45° field of view · retinal fundus photograph
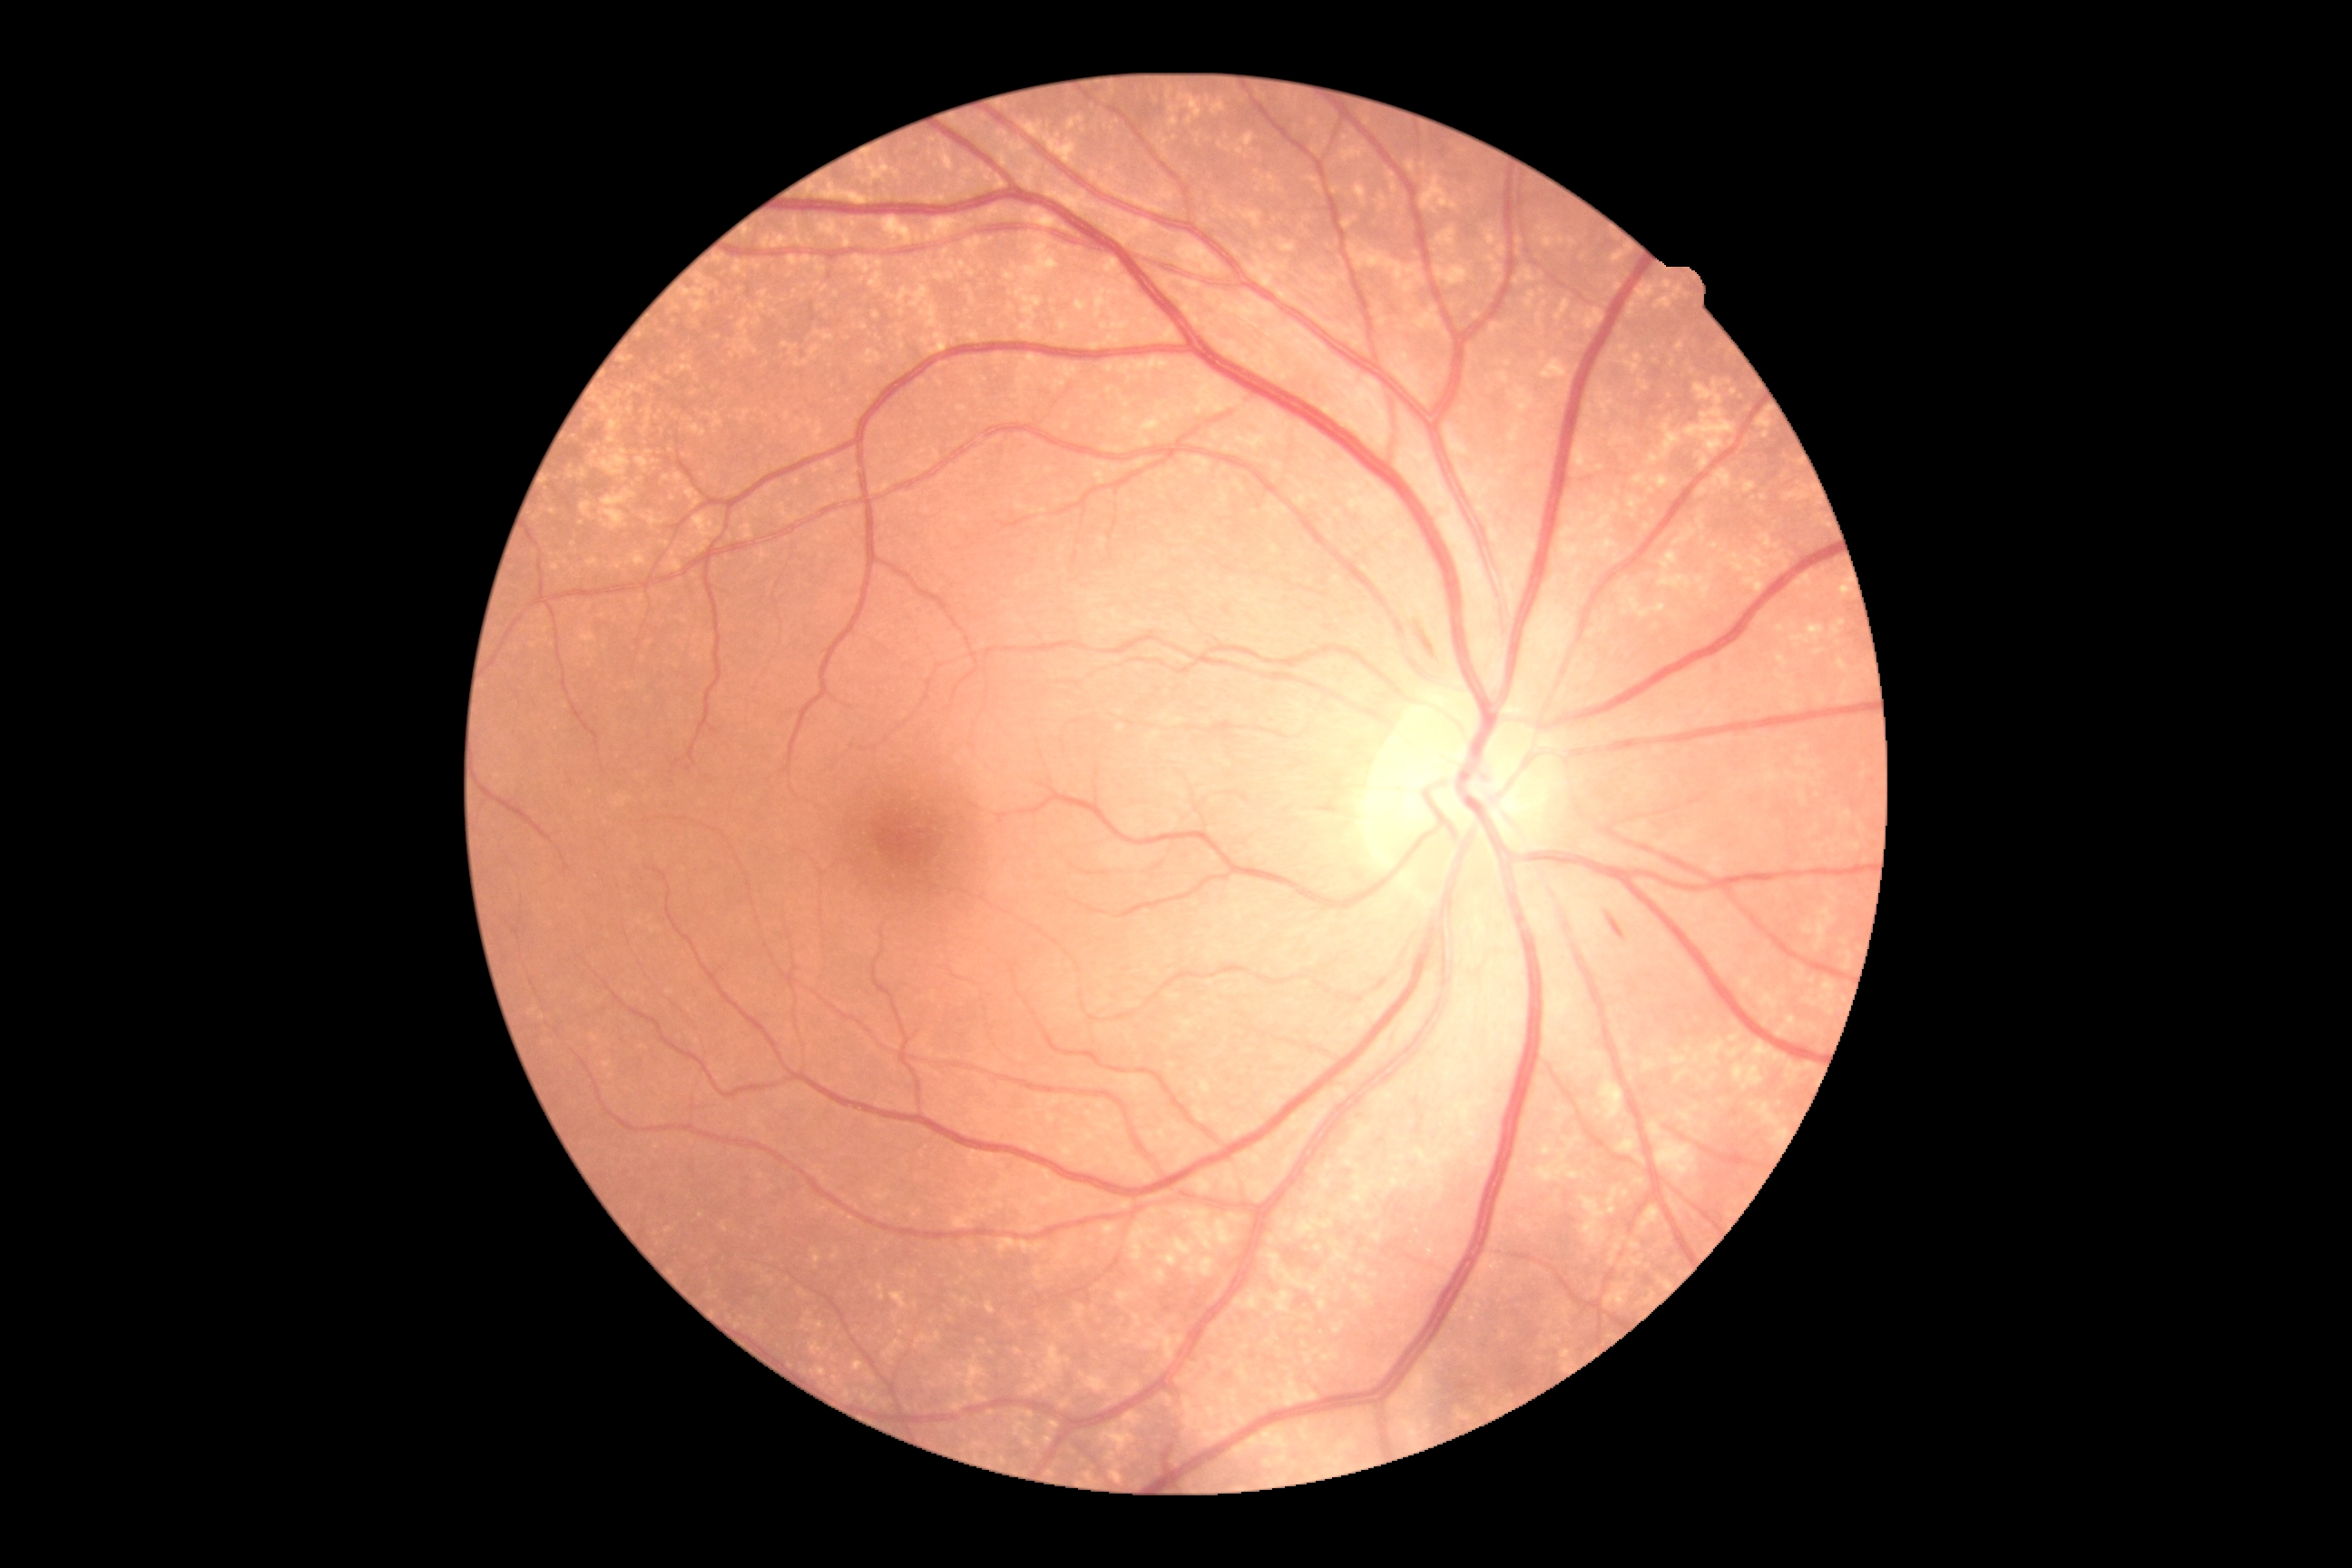
Diabetic retinopathy grade: 2 (moderate NPDR).